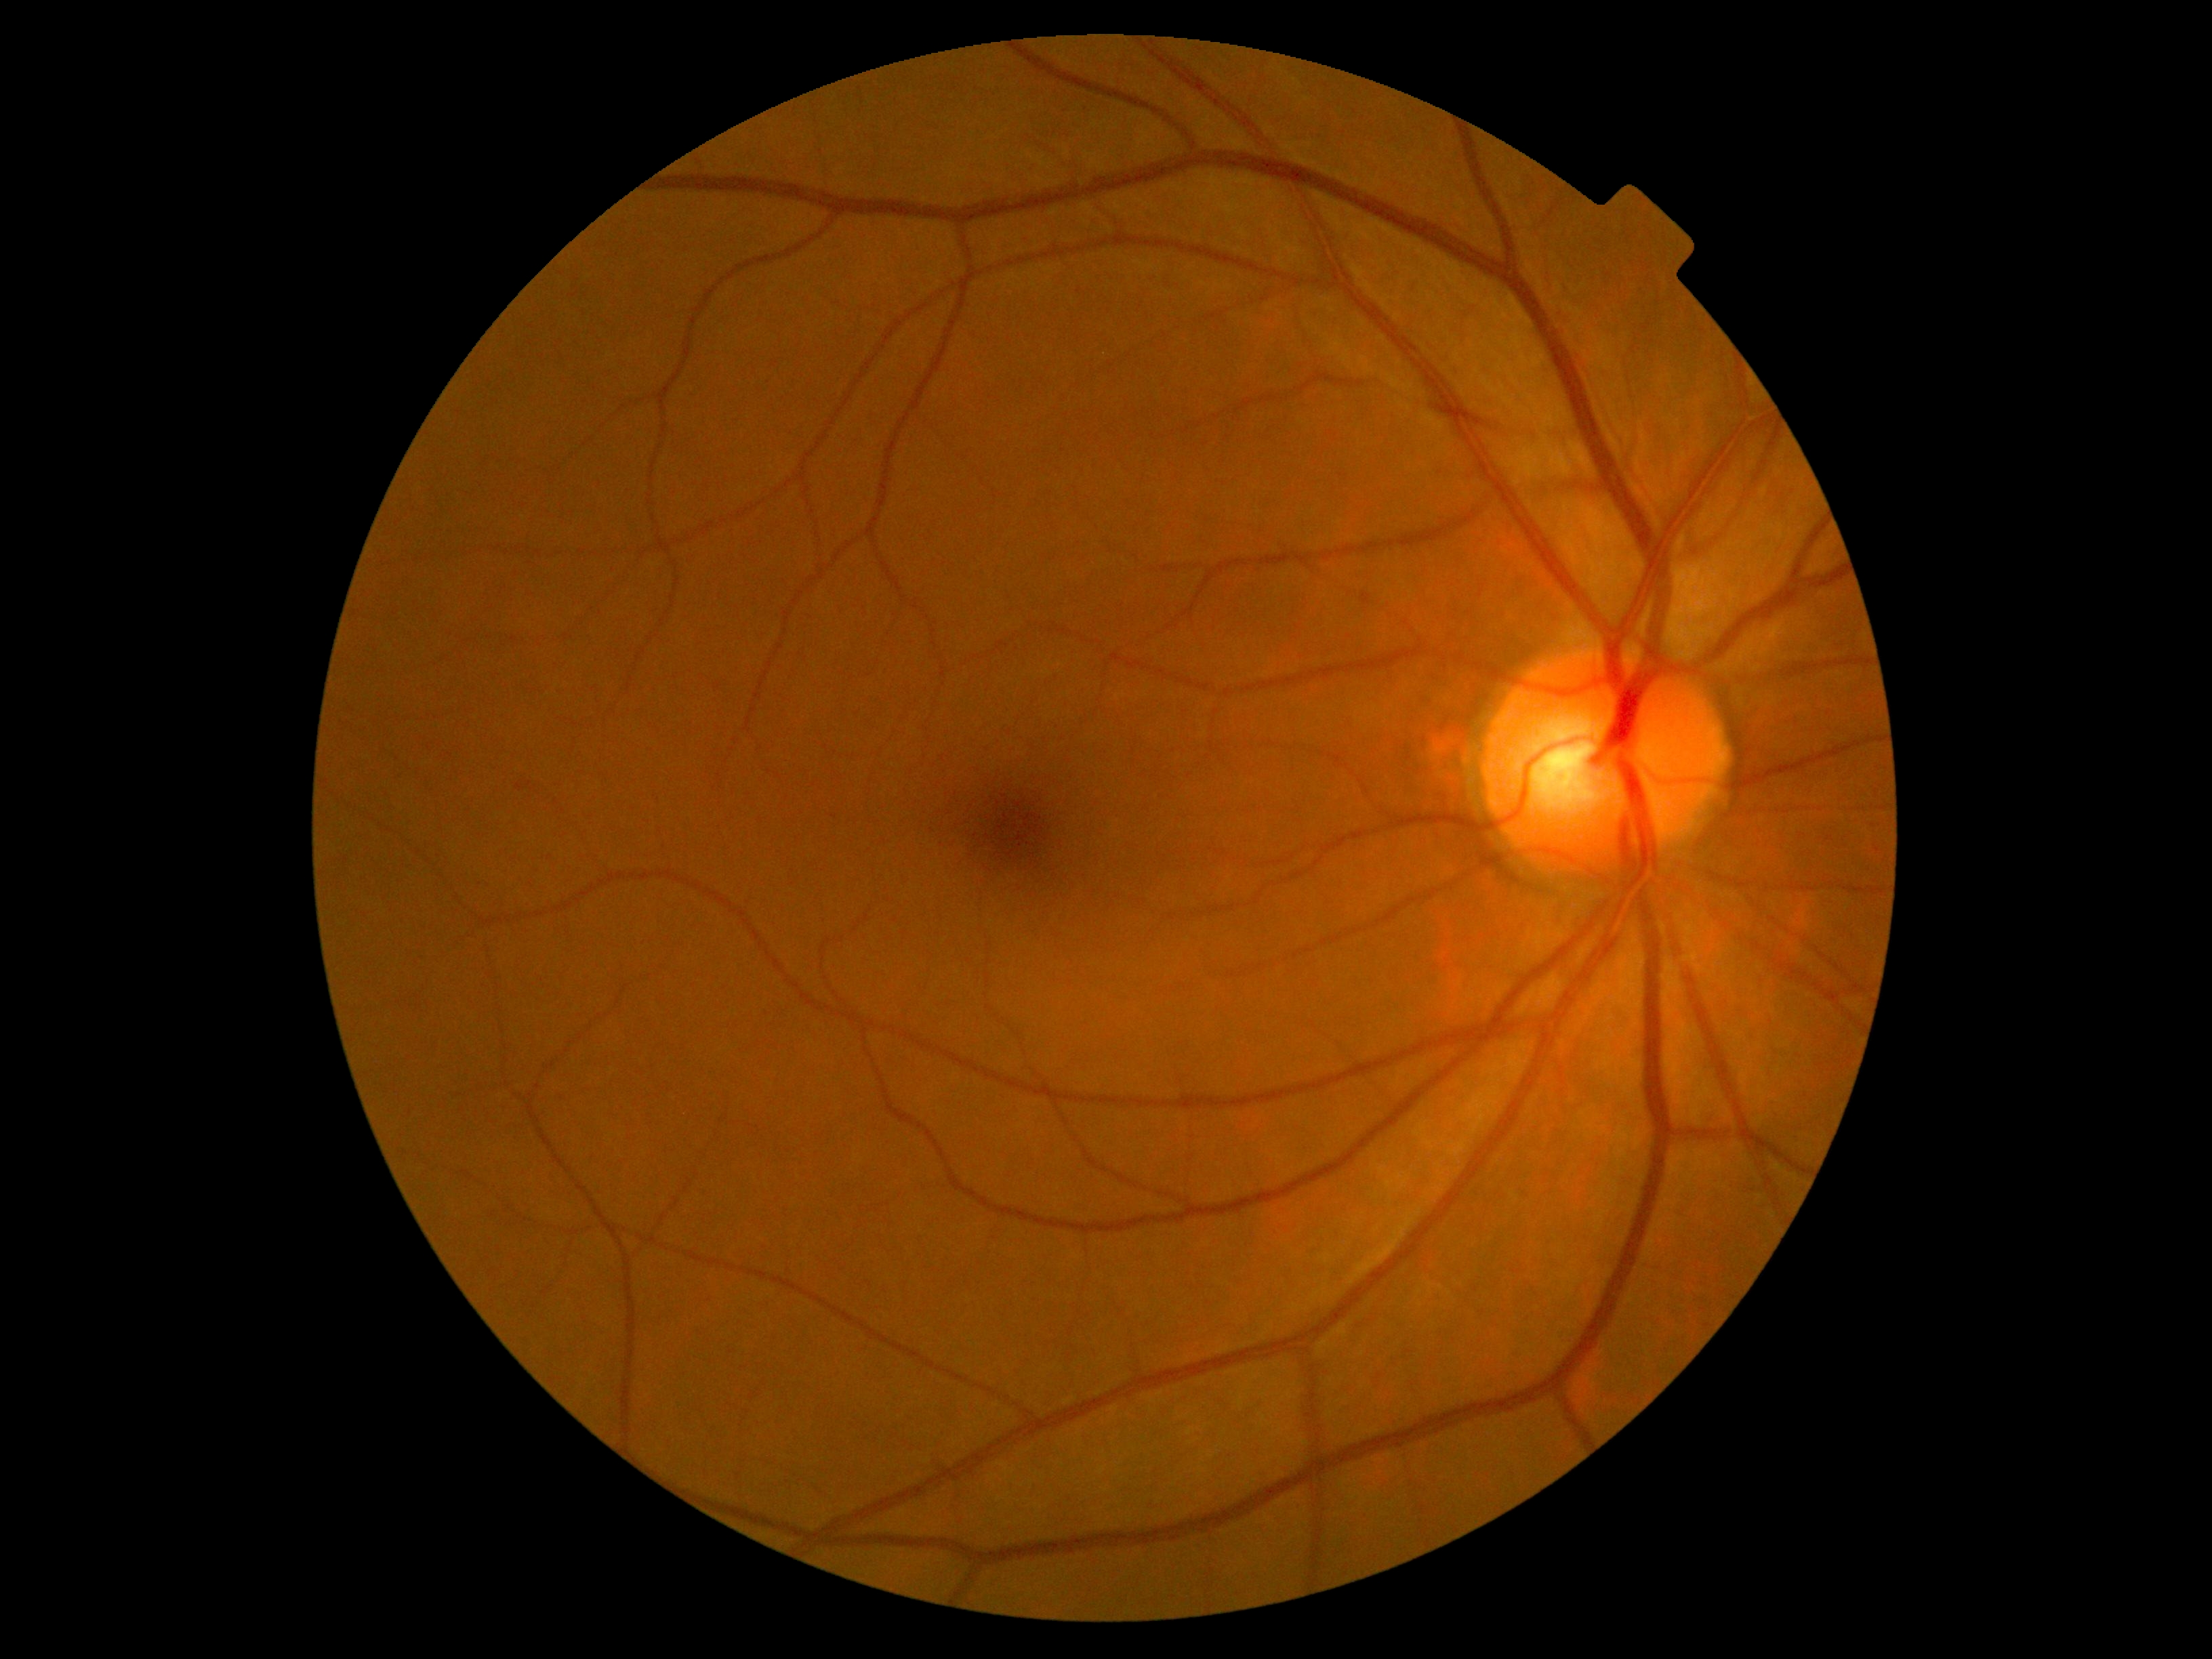
{"dr_grade": "grade 0 (no apparent retinopathy) — no visible signs of diabetic retinopathy", "dr_impression": "no DR findings"}